Fundus photo
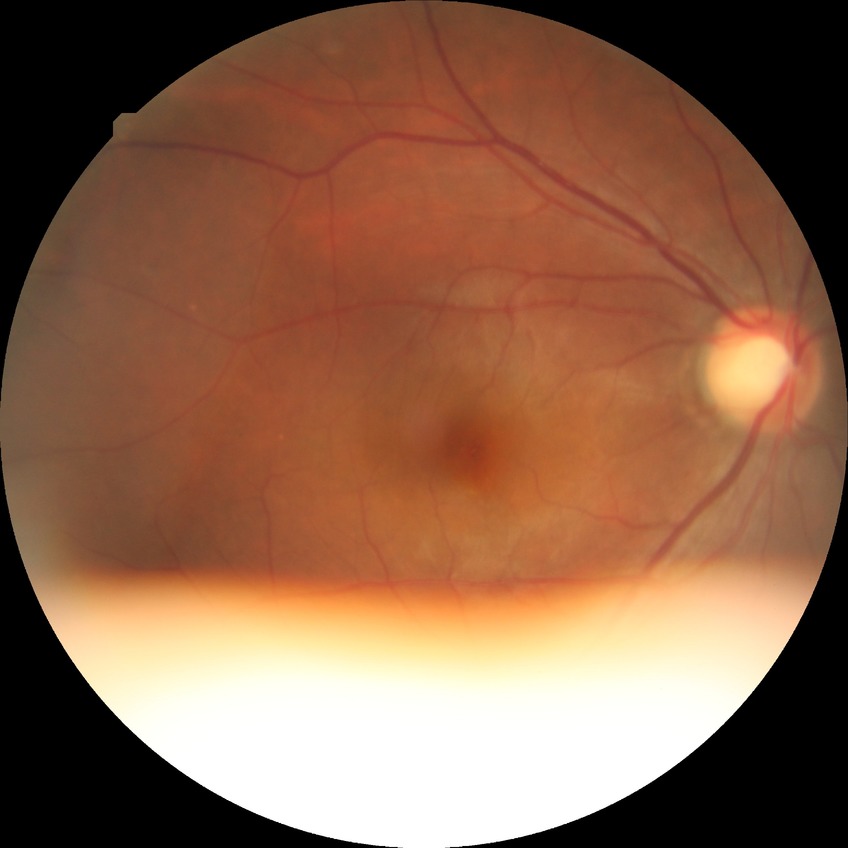 Davis grading = no diabetic retinopathy.